Retinal fundus photograph · 45° FOV:
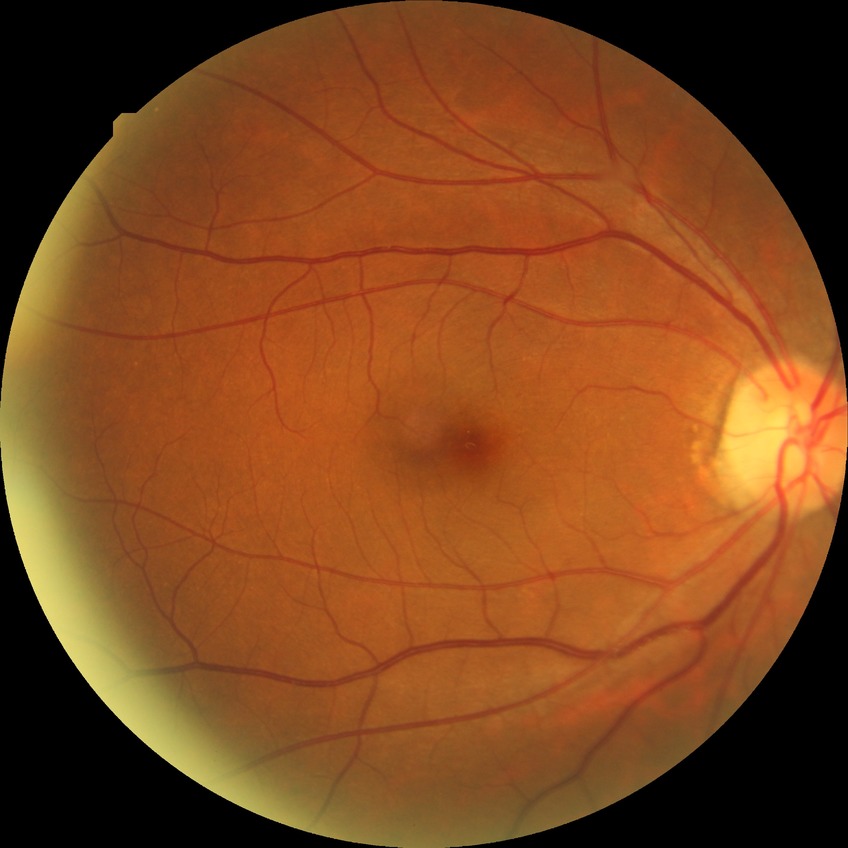
- modified Davis grading — no diabetic retinopathy